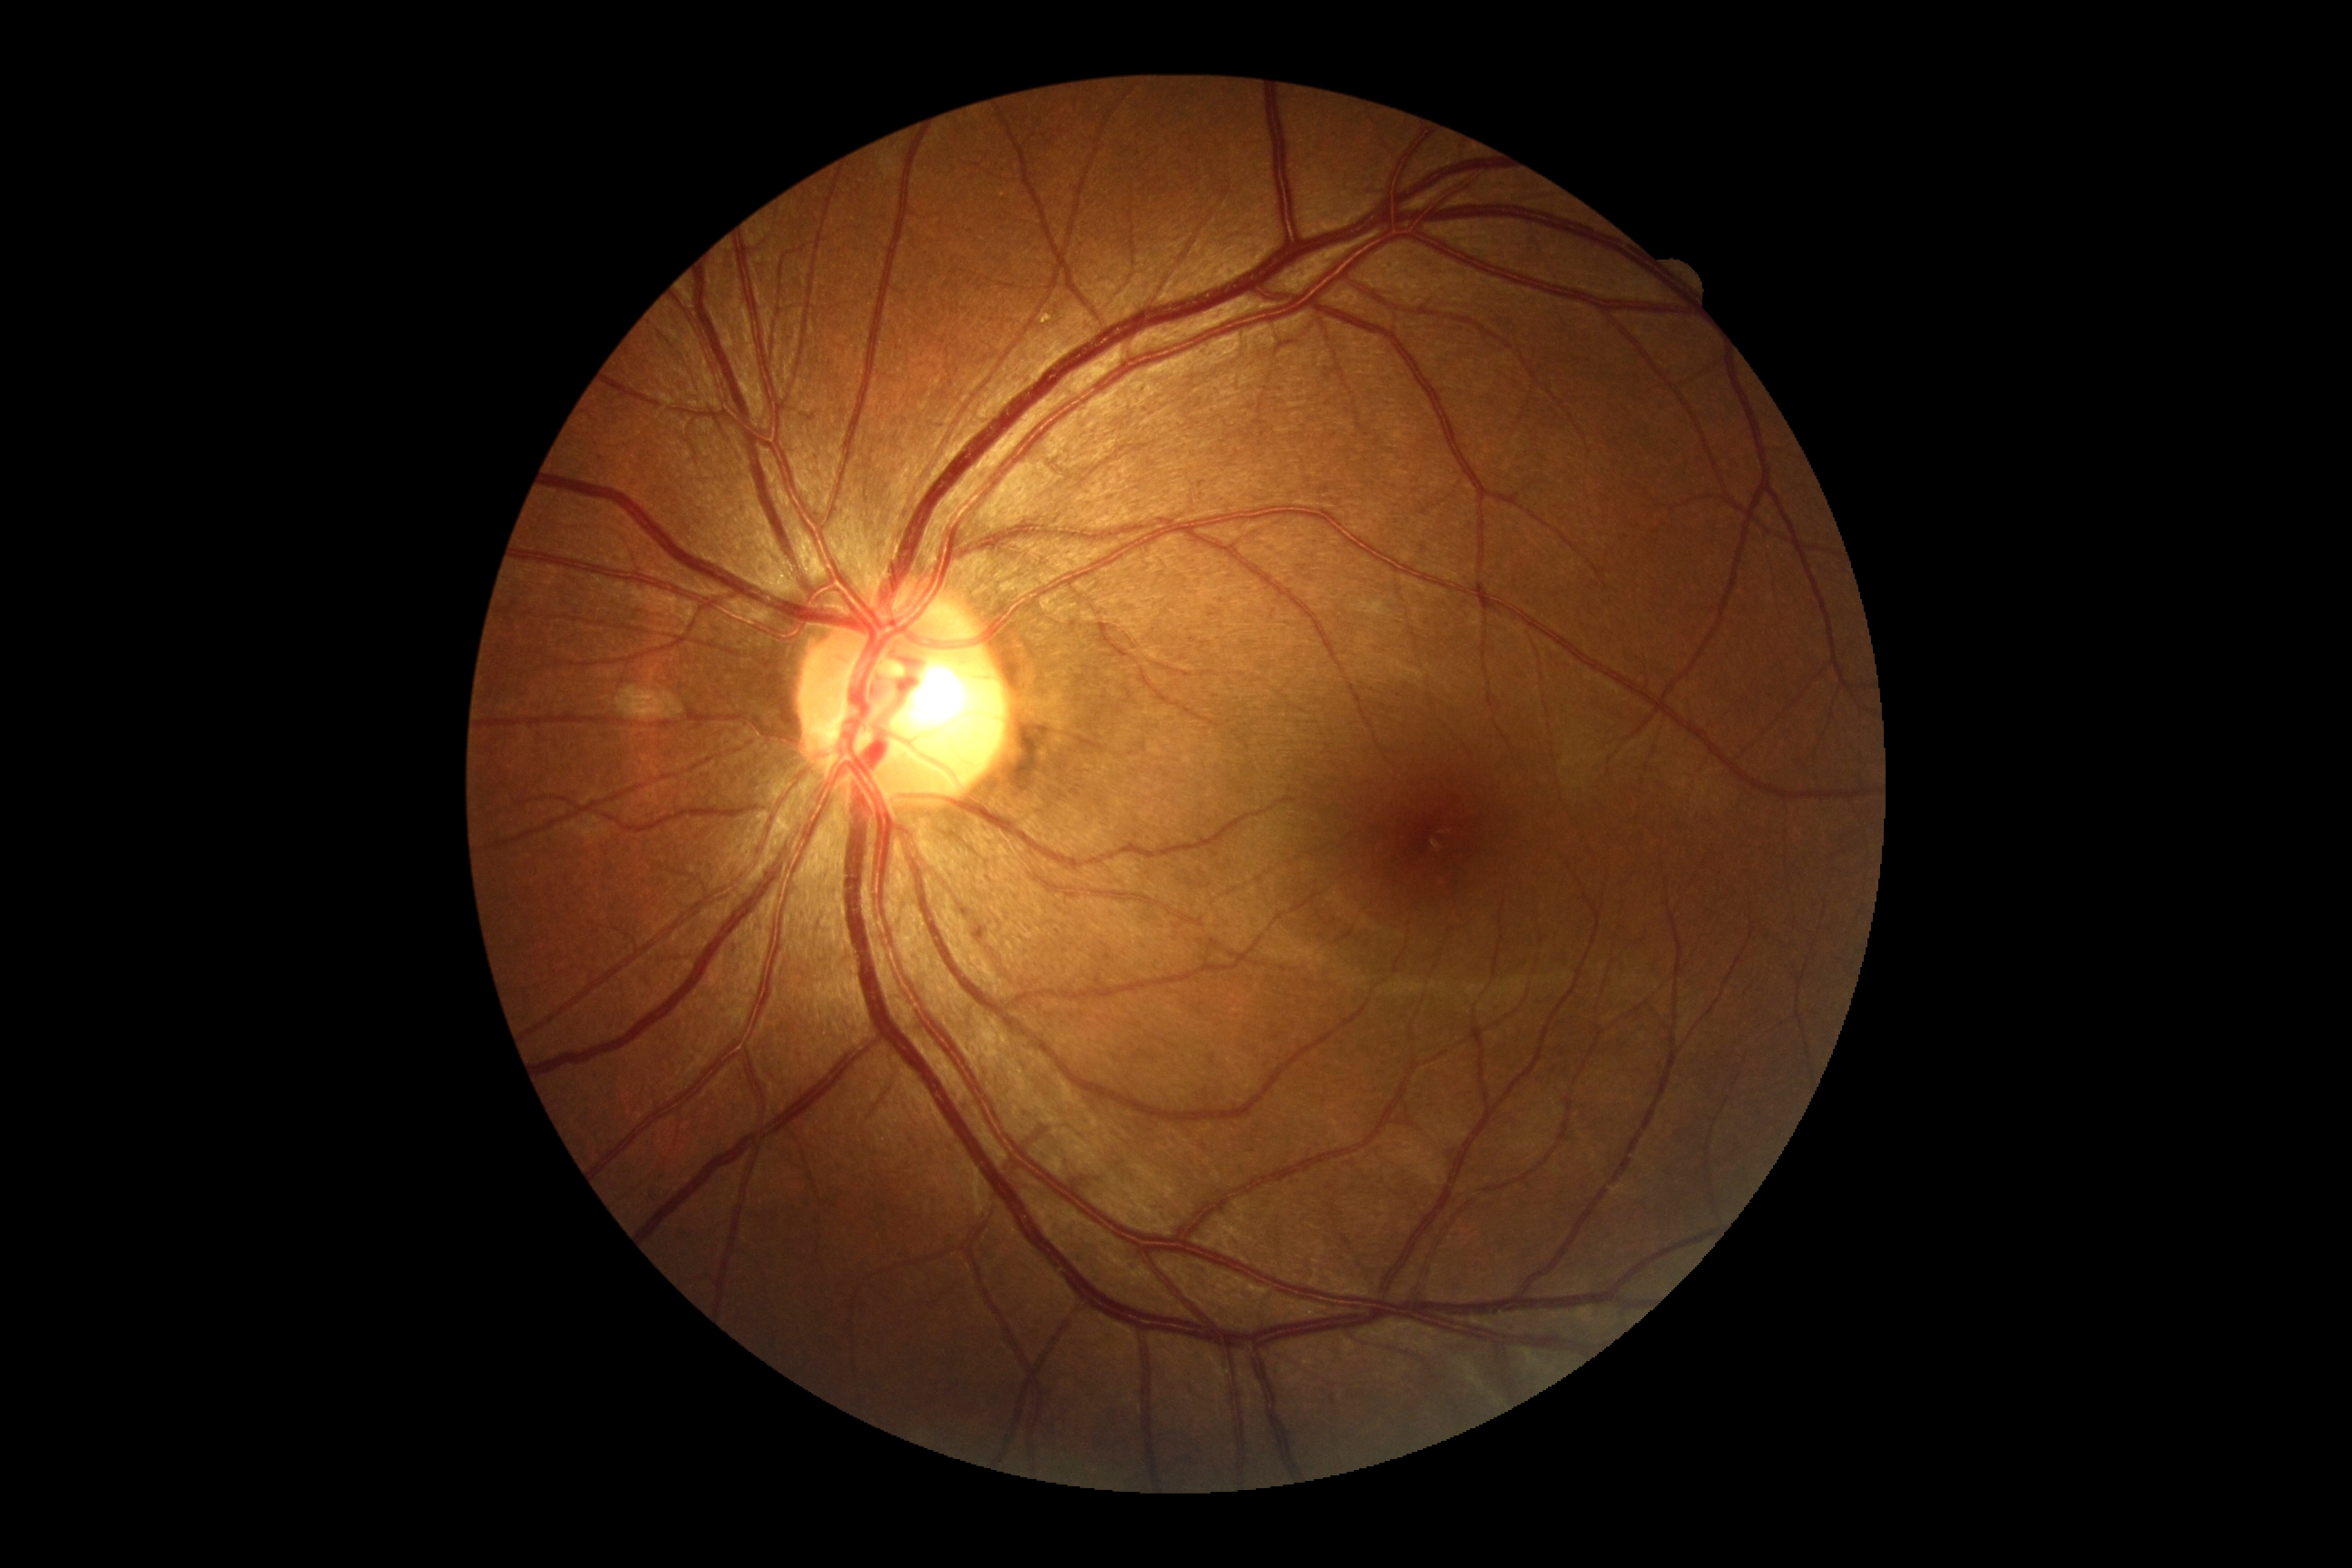
DR impression=negative for DR, diabetic retinopathy (DR)=grade 0 (no apparent retinopathy).